30° field of view.
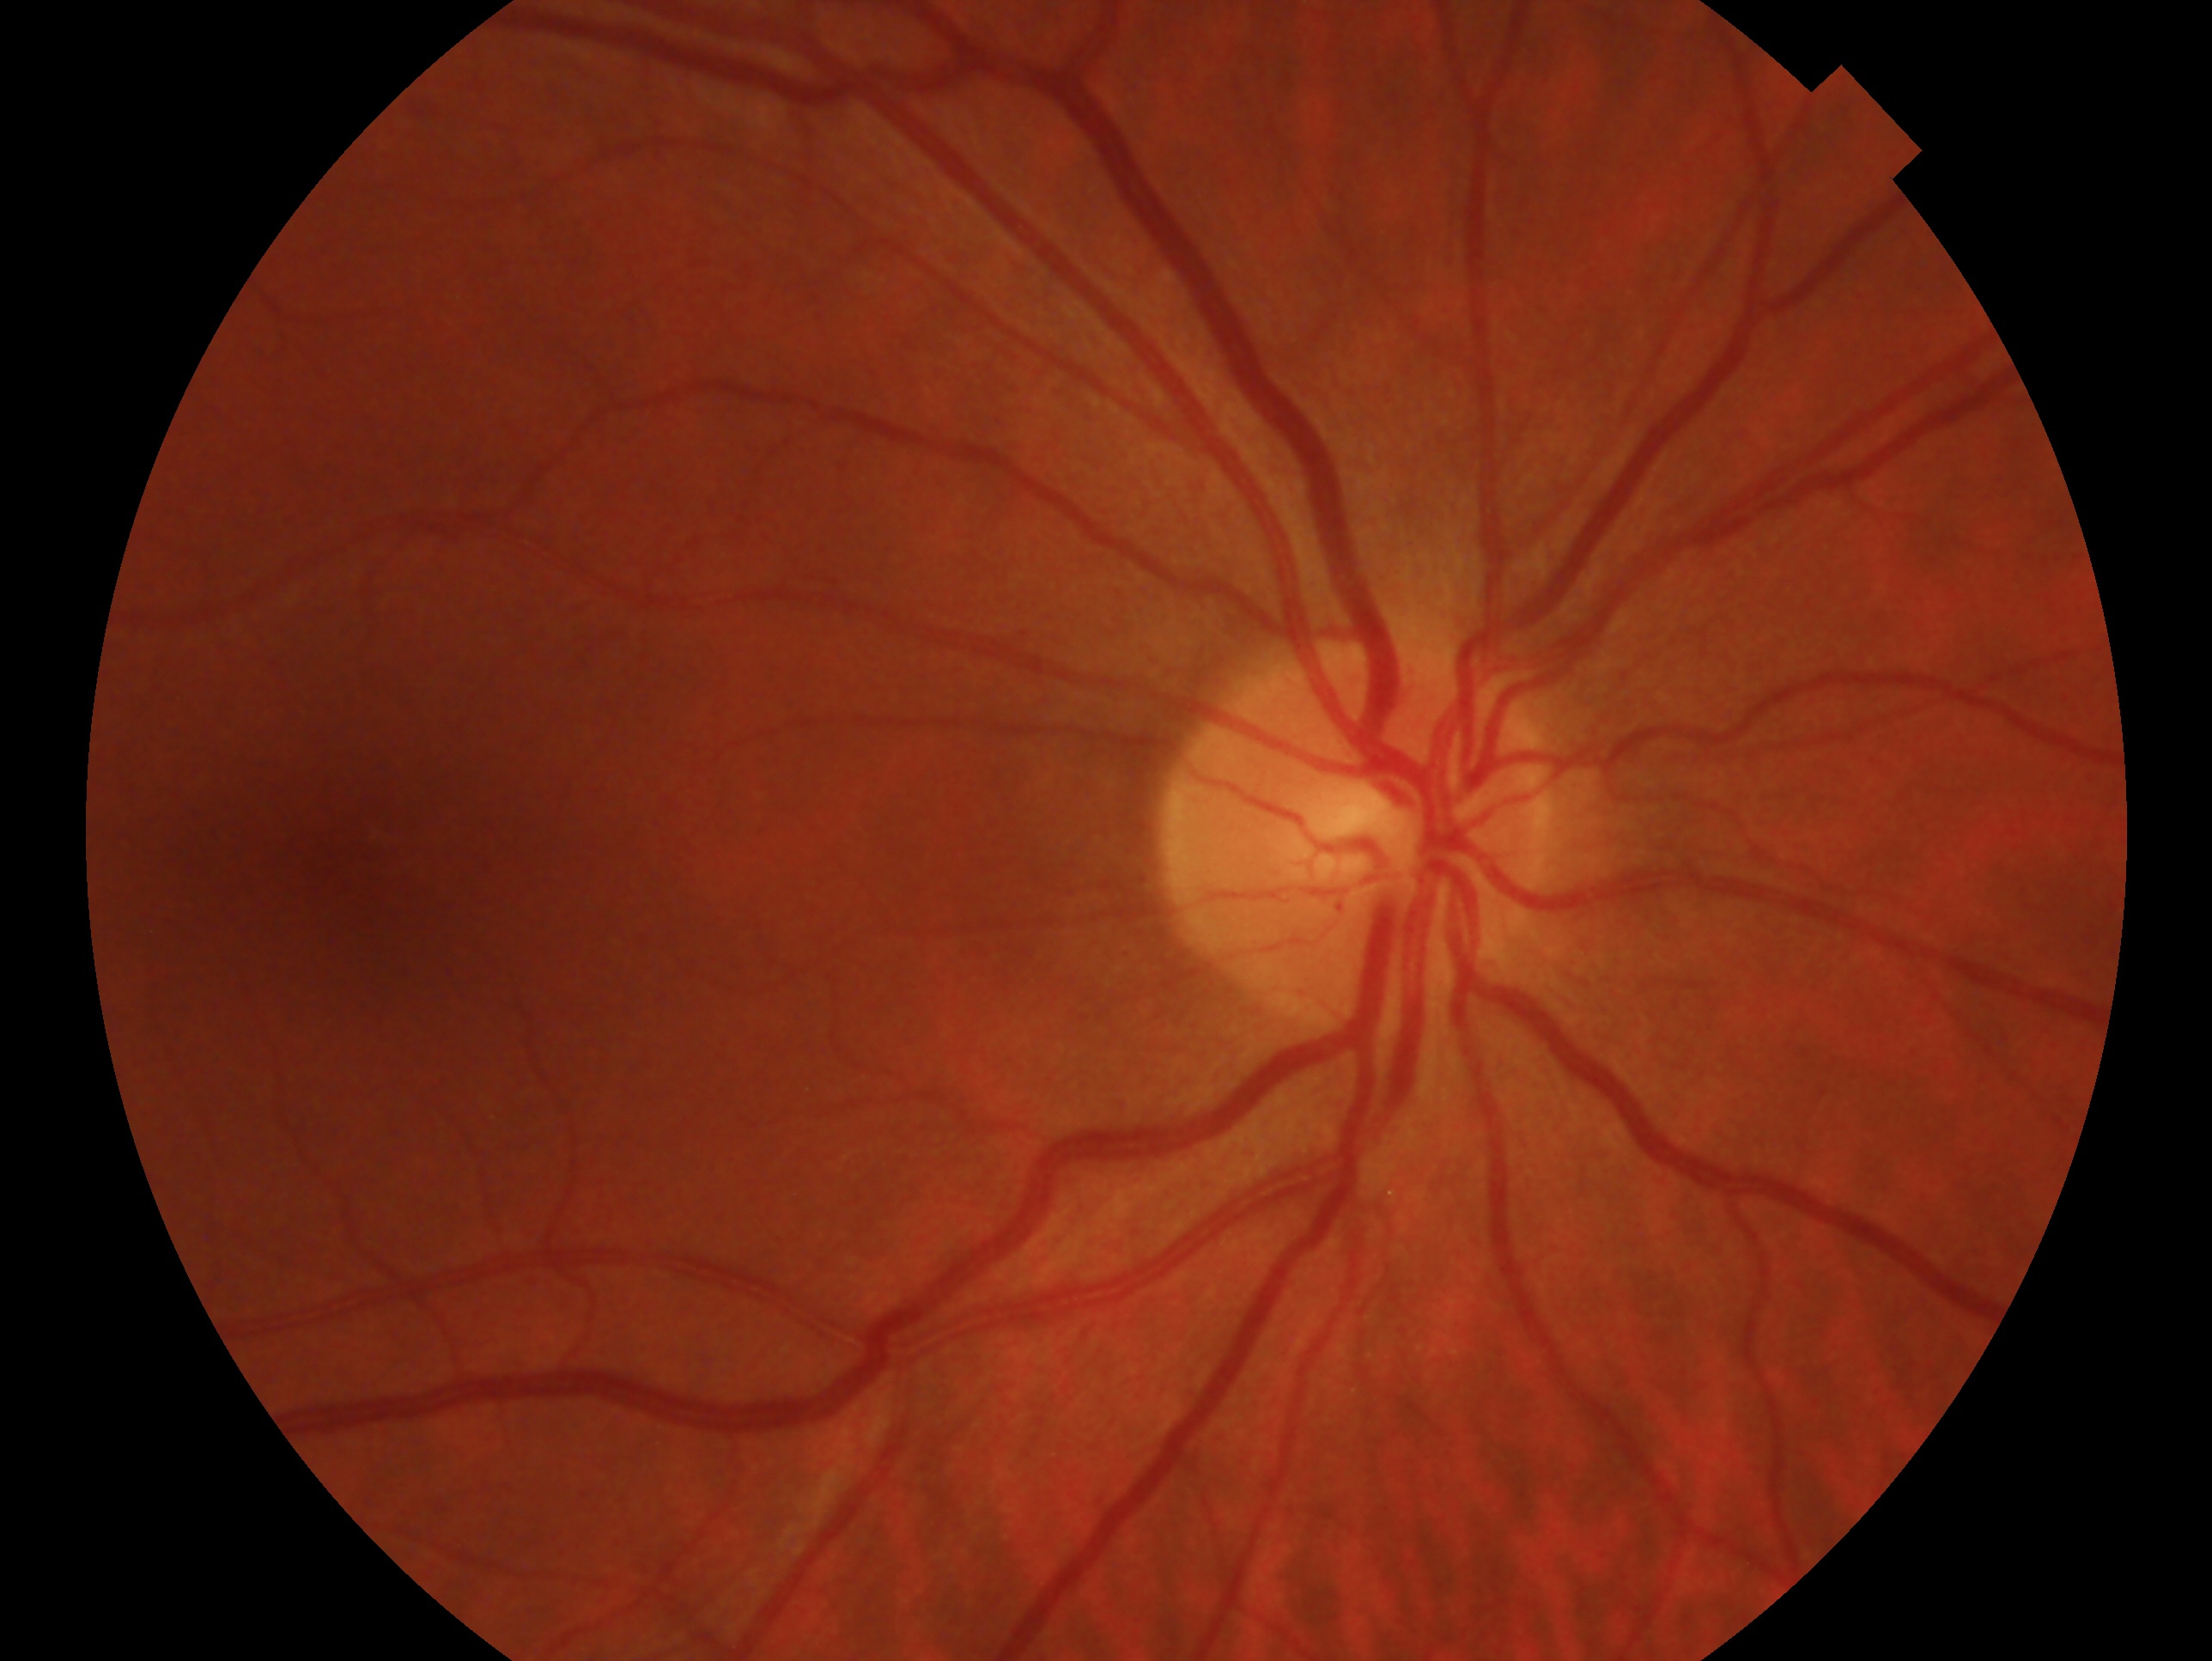
Diagnosis — no signs of glaucoma.
This is the oculus dexter.